Retinal fundus photograph.
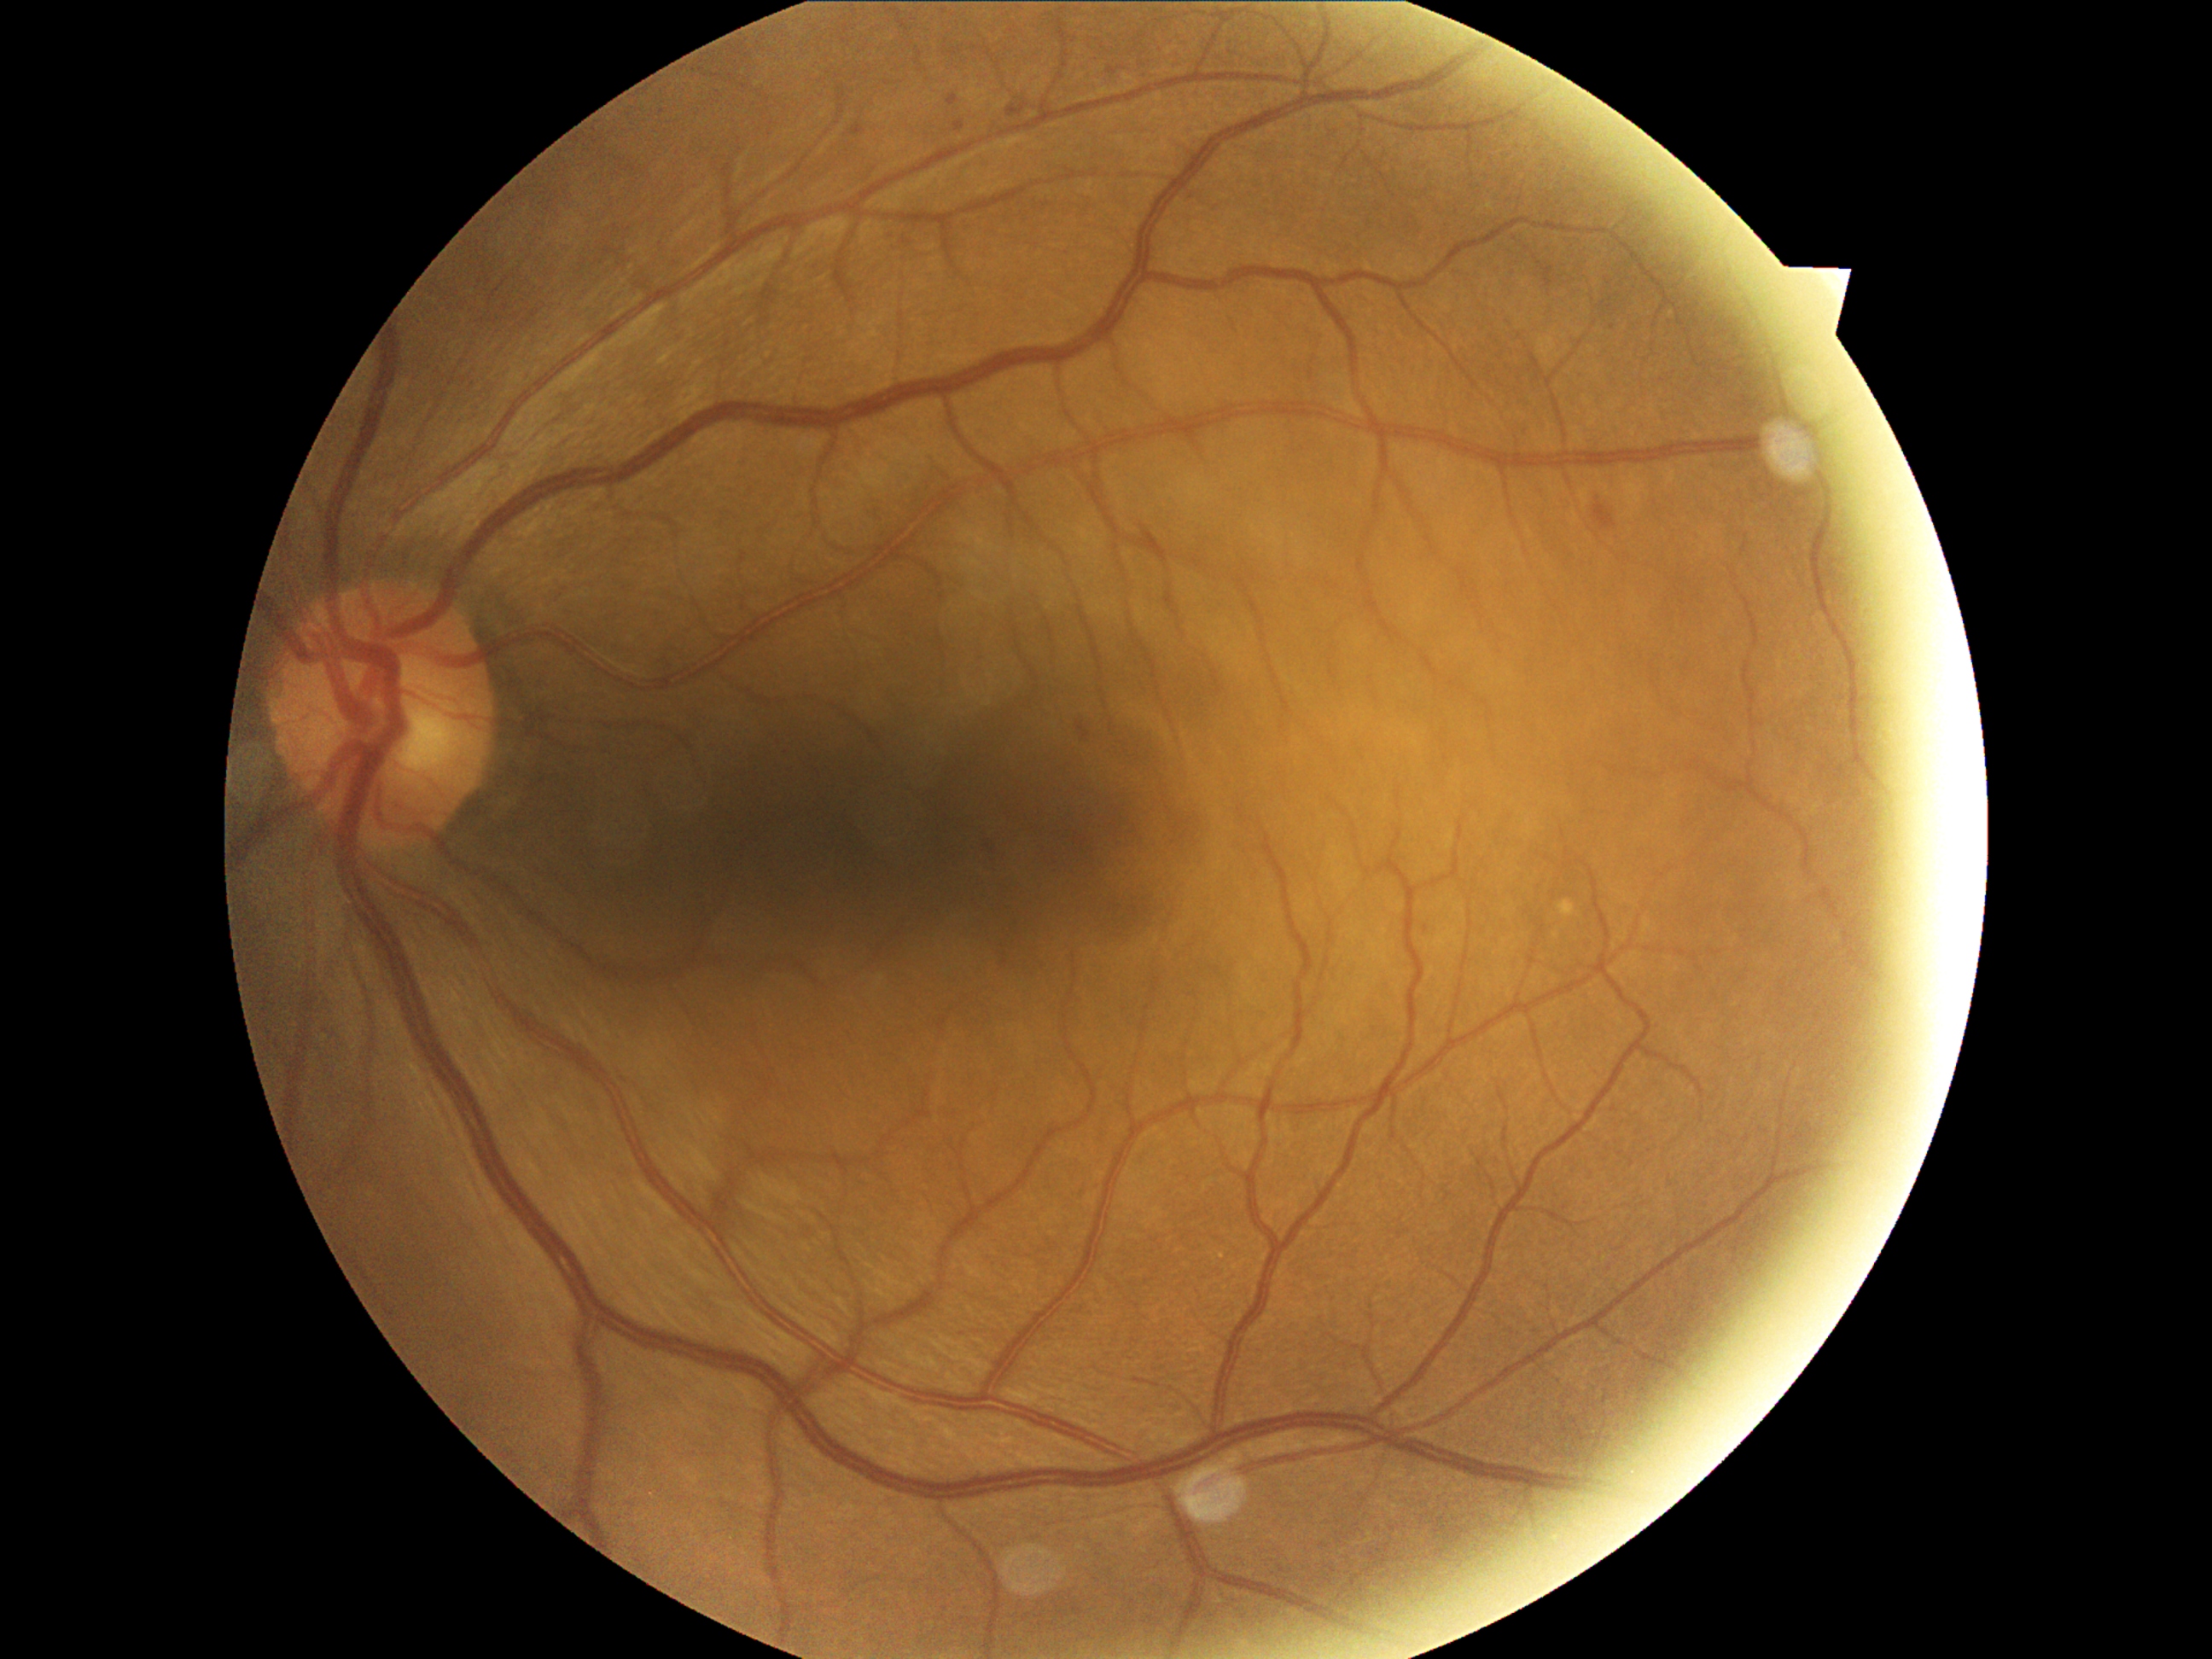 DR grade is 2 — more than just microaneurysms but less than severe NPDR.